848 by 848 pixels
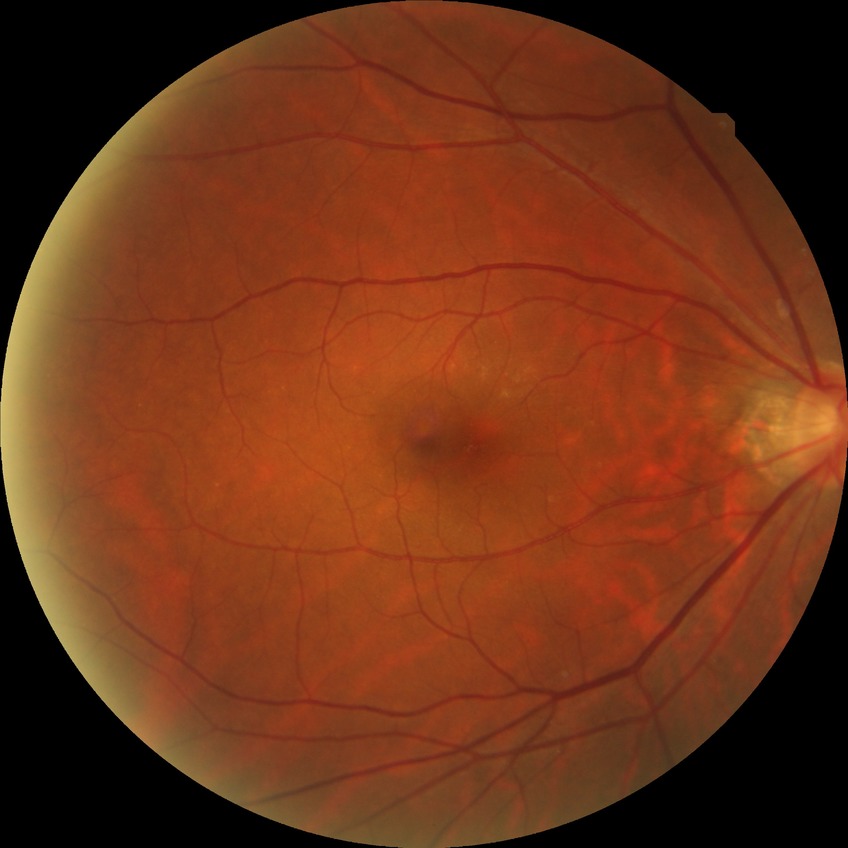 Diabetic retinopathy (DR): no diabetic retinopathy (NDR).